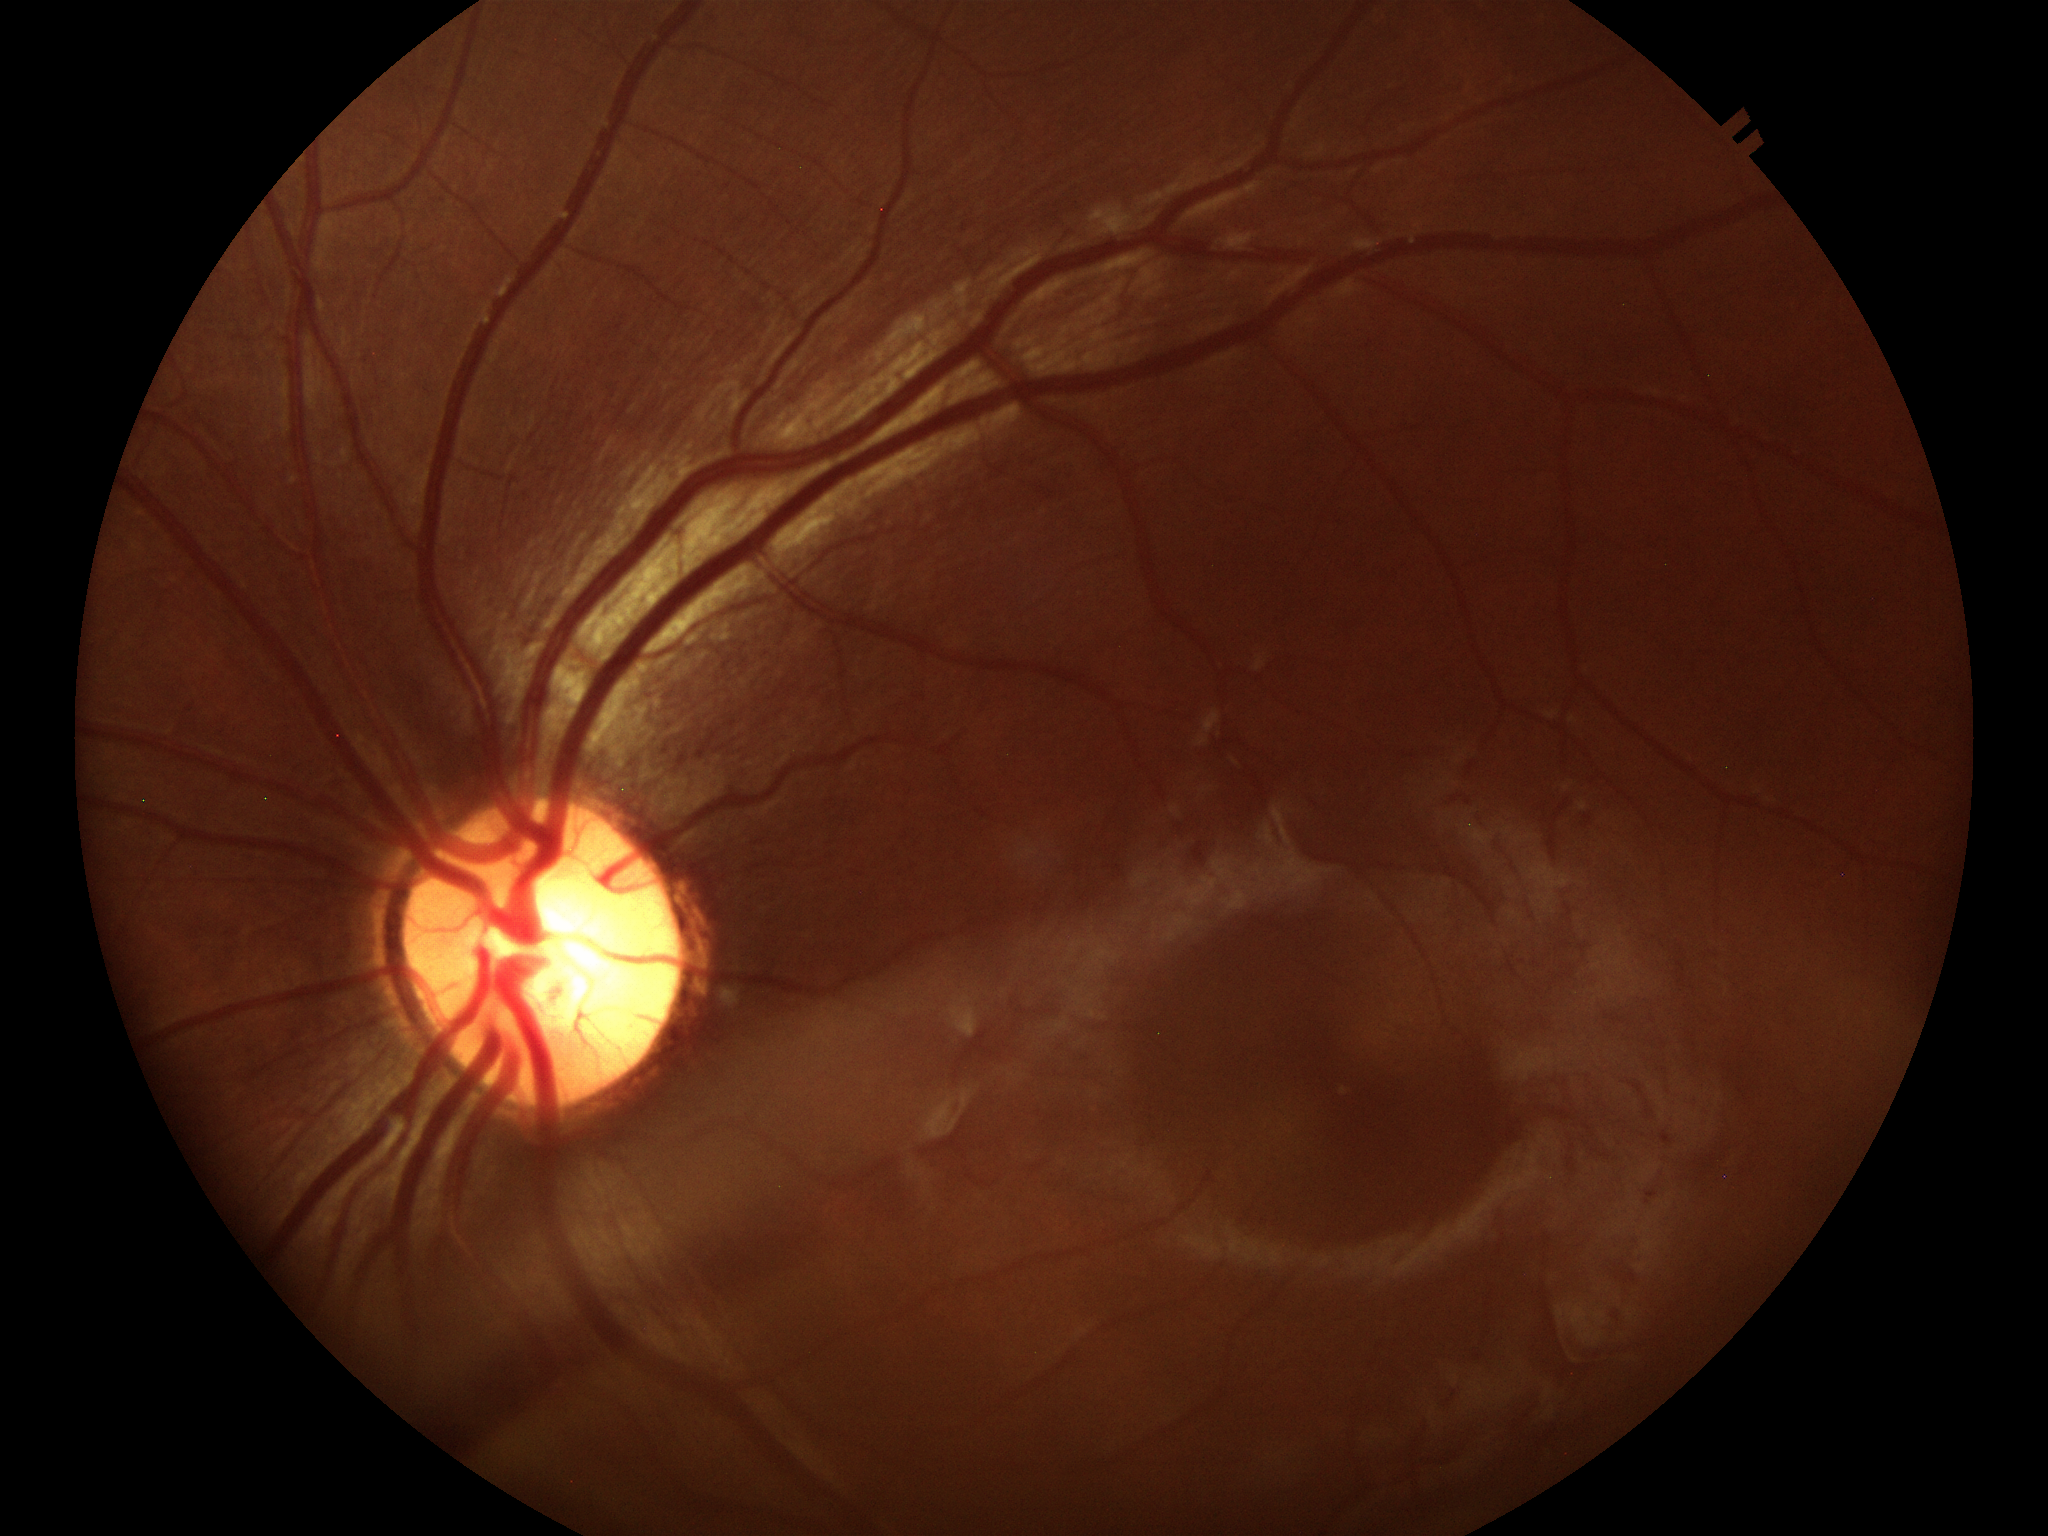 vertical cup-to-disc ratio (VCDR) = 0.61, Glaucoma decision = no suspicious findings.